No pharmacologic dilation · diabetic retinopathy graded by the modified Davis classification: 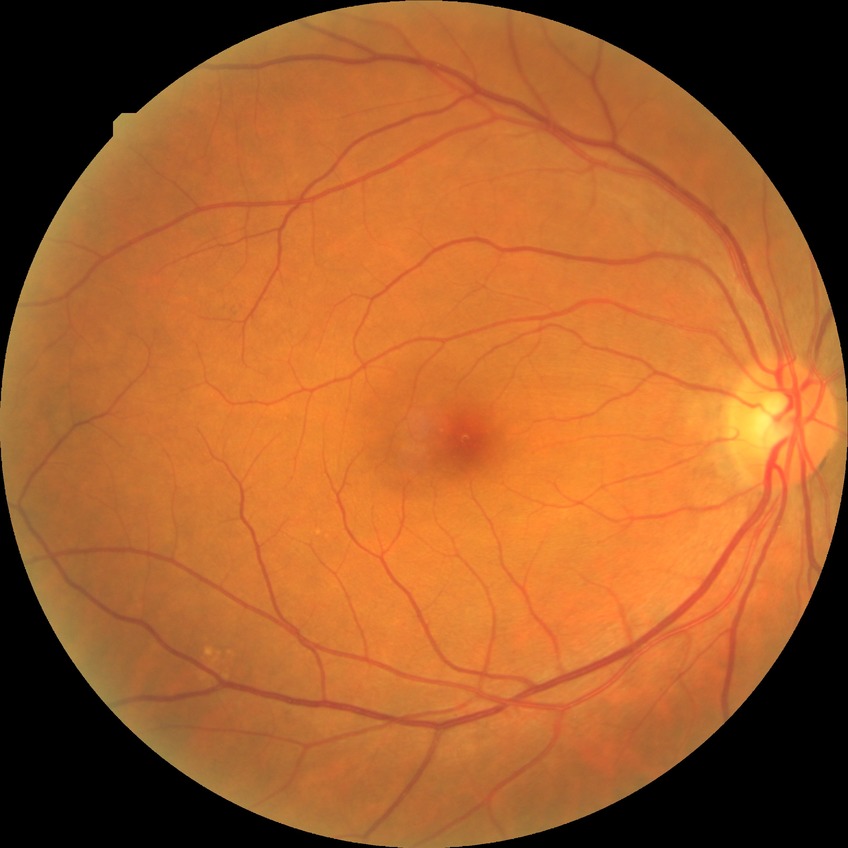
Diabetic retinopathy (DR) is NDR (no diabetic retinopathy).